Cropped to the optic nerve head — 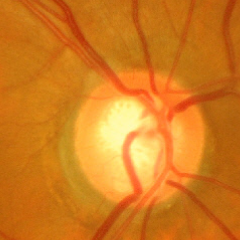

Findings consistent with glaucoma. Glaucoma assessment: advanced glaucomatous optic neuropathy.